Posterior pole photograph: 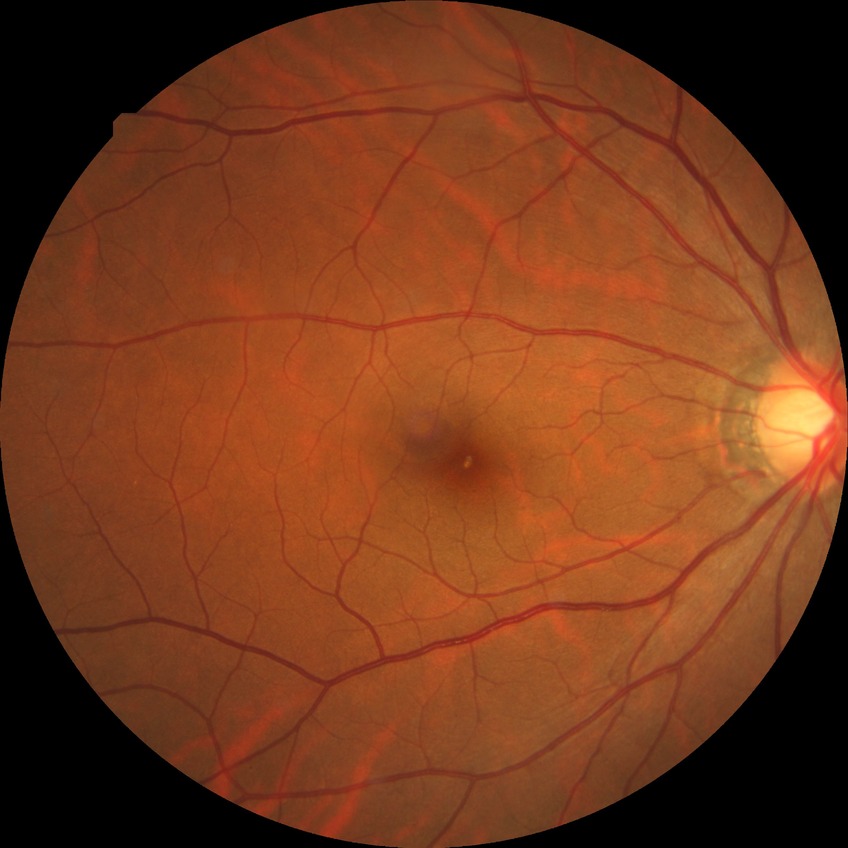

Modified Davis grading: simple diabetic retinopathy.